45° FOV.
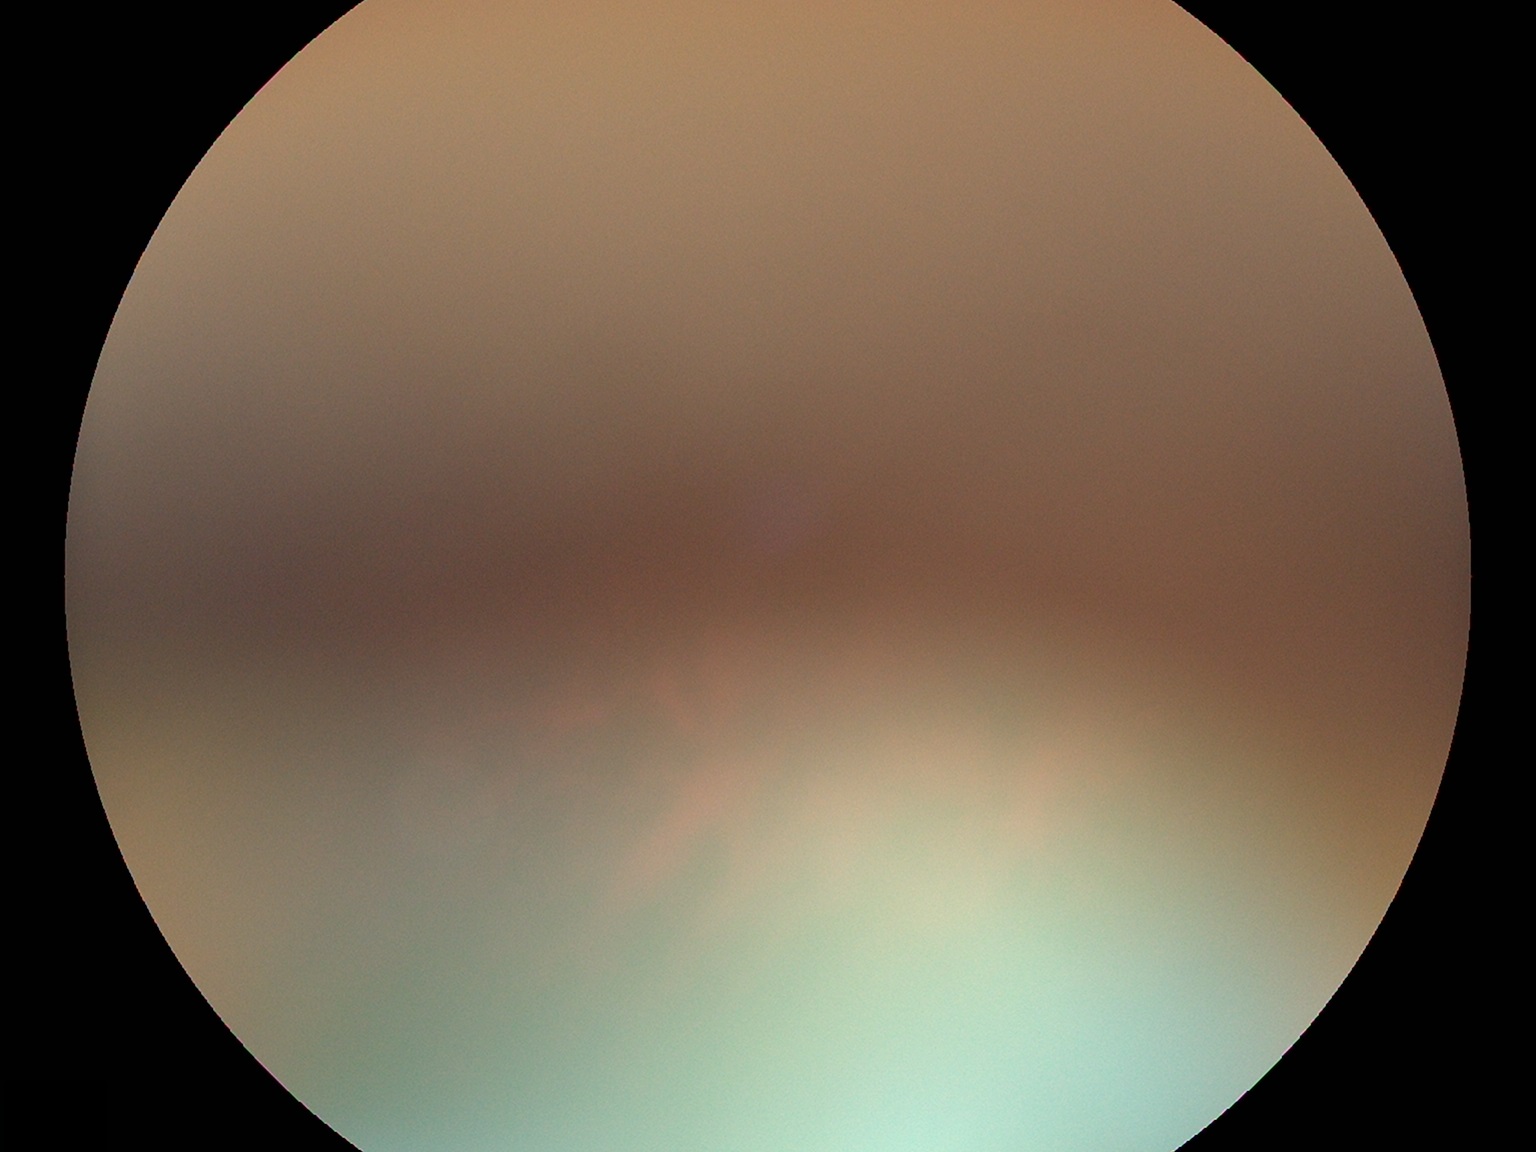

diabetic retinopathy: ungradable due to poor image quality; image quality: below grading threshold.